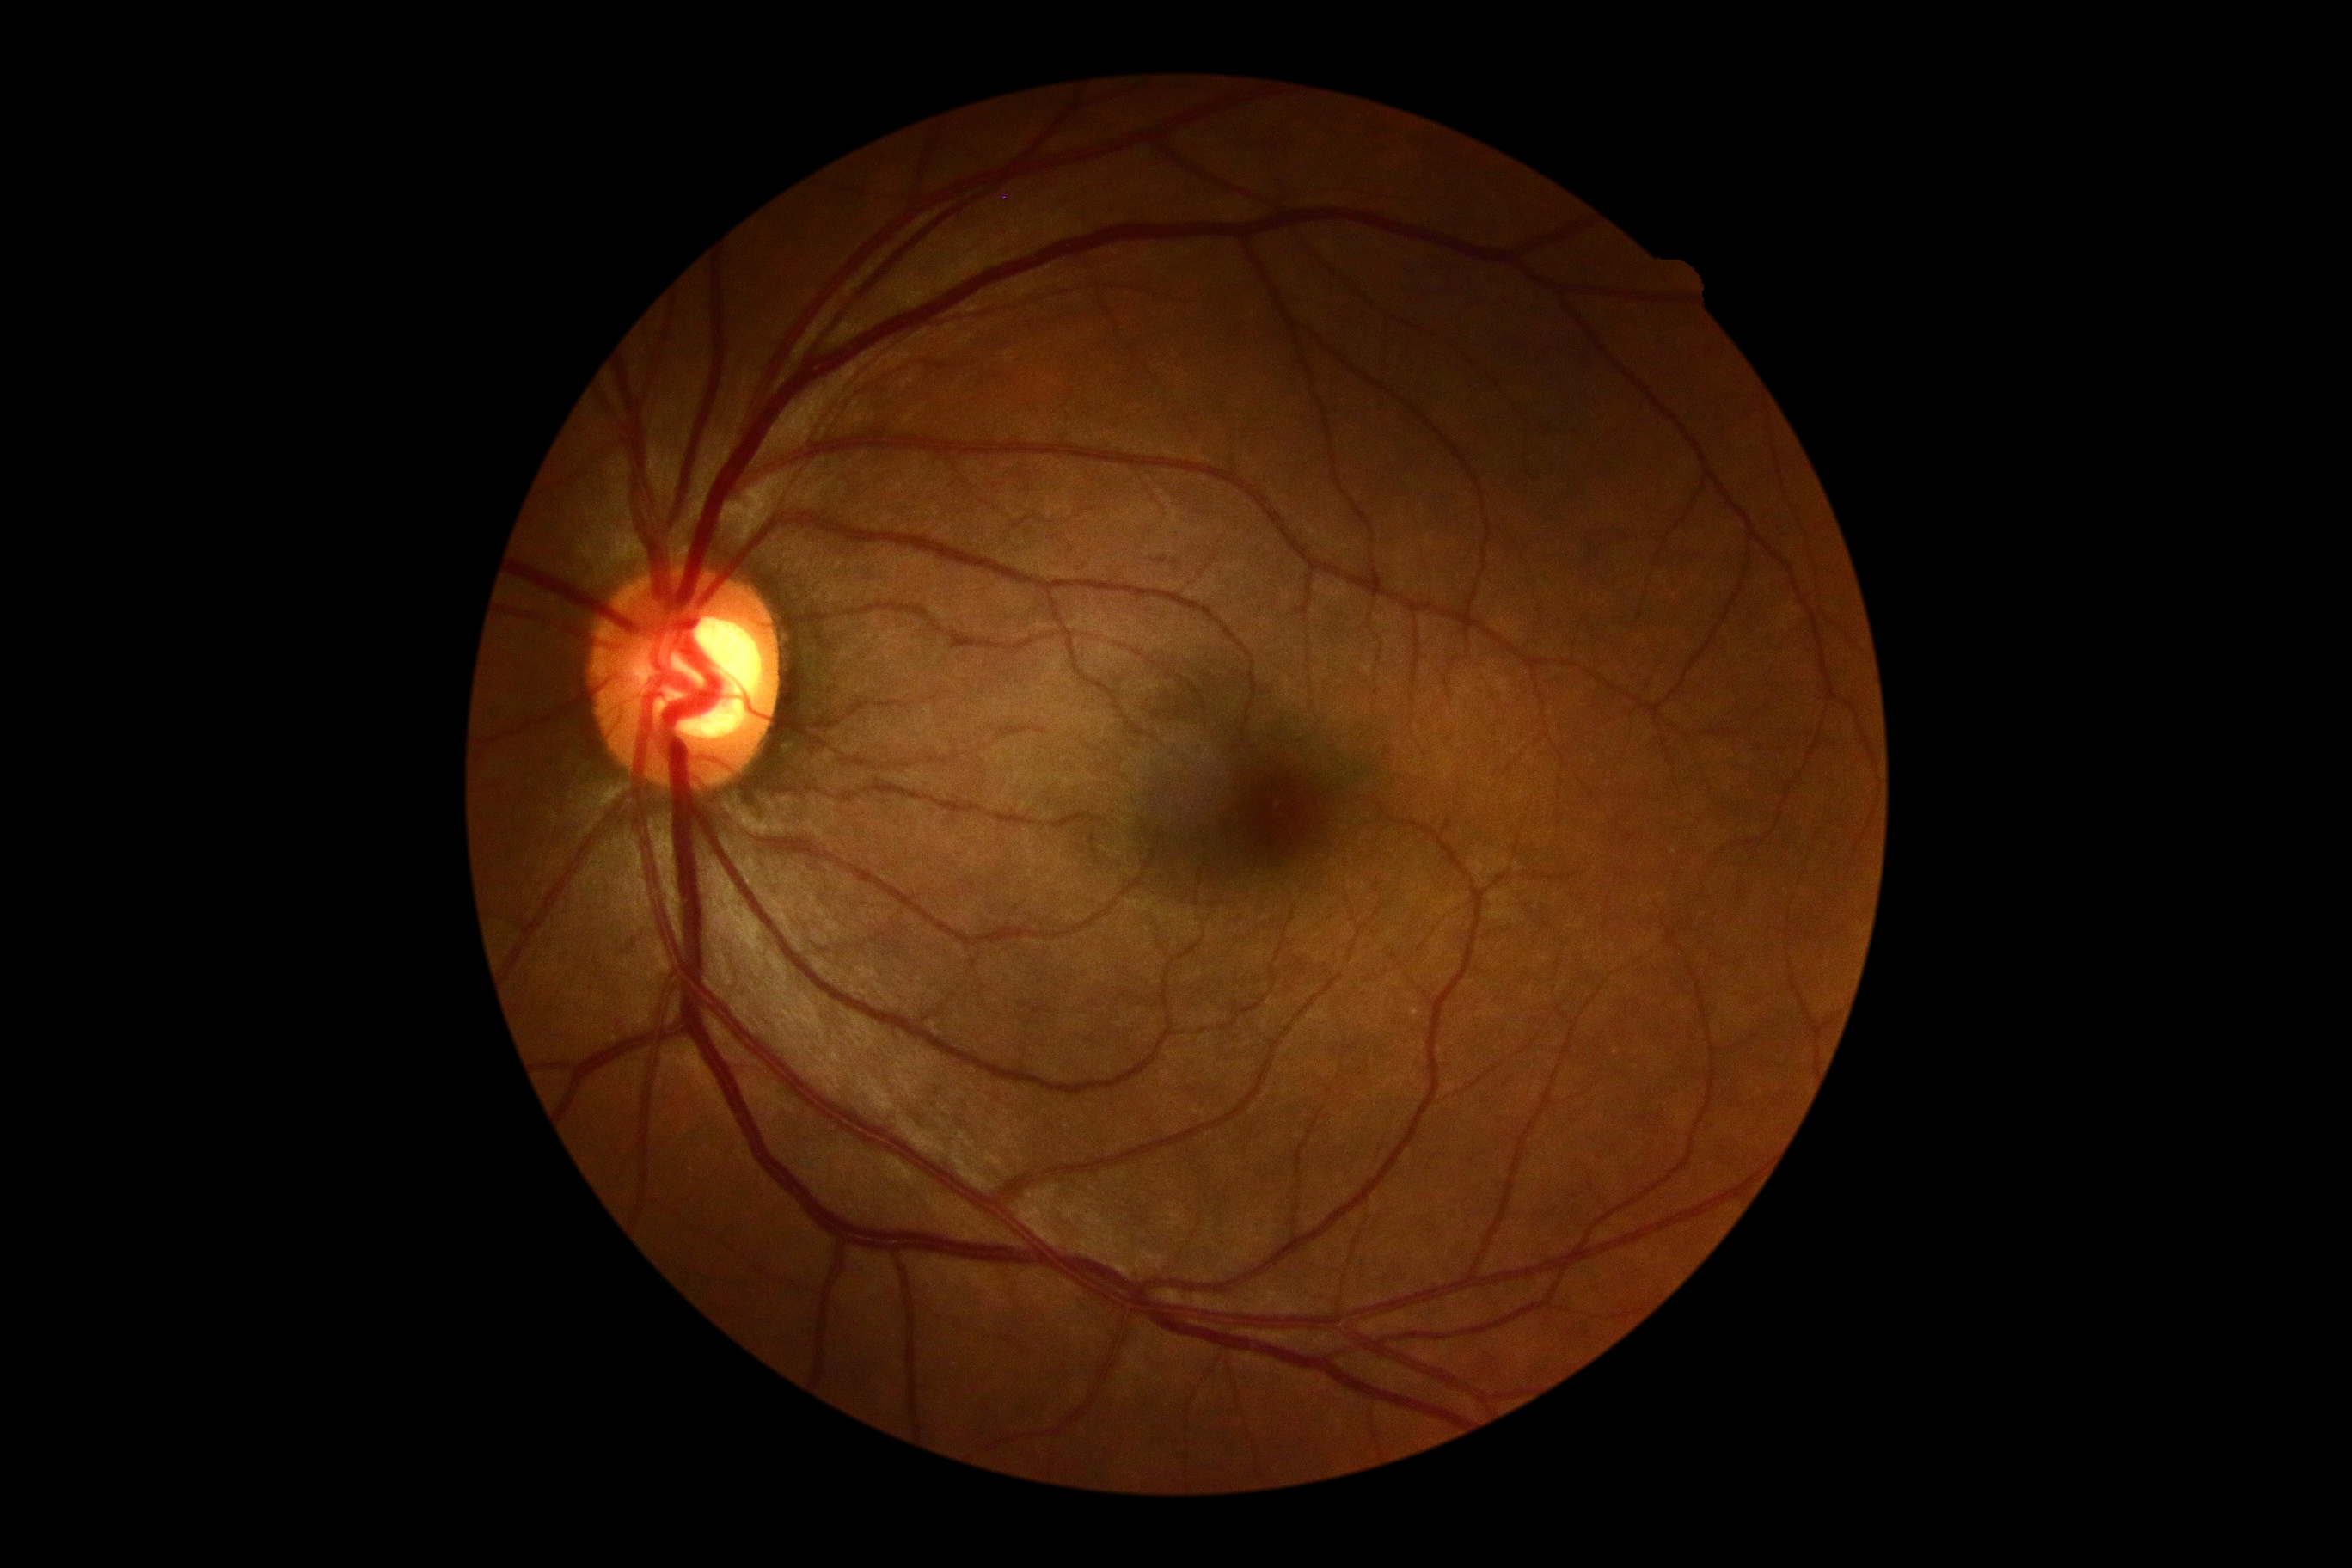 No DR findings.
Retinopathy: no apparent diabetic retinopathy (grade 0).